Image size 1240x1240. Wide-field fundus photograph of an infant — 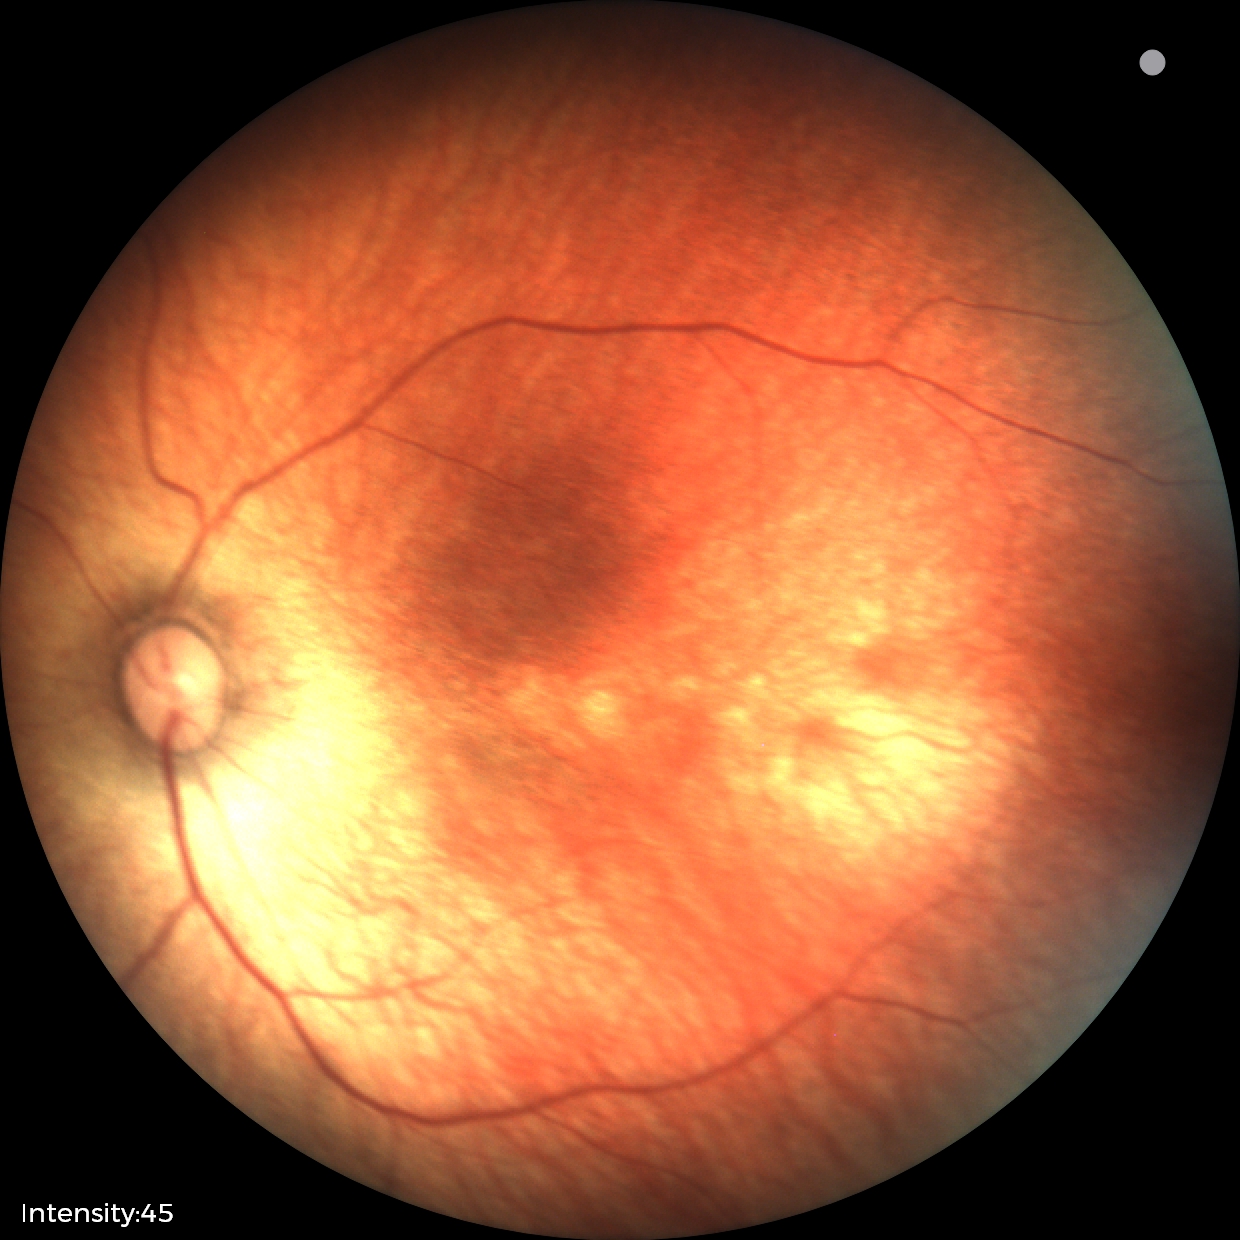 Physiological retinal appearance for postconceptual age.